640x480 · wide-field fundus photograph from neonatal ROP screening
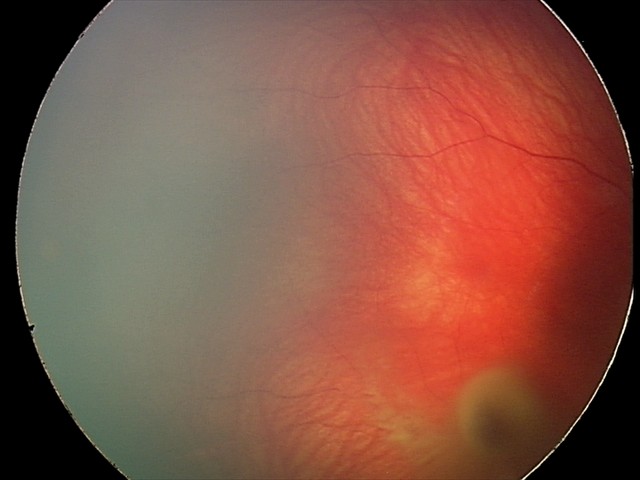

Examination diagnosed as retinal hemorrhages.